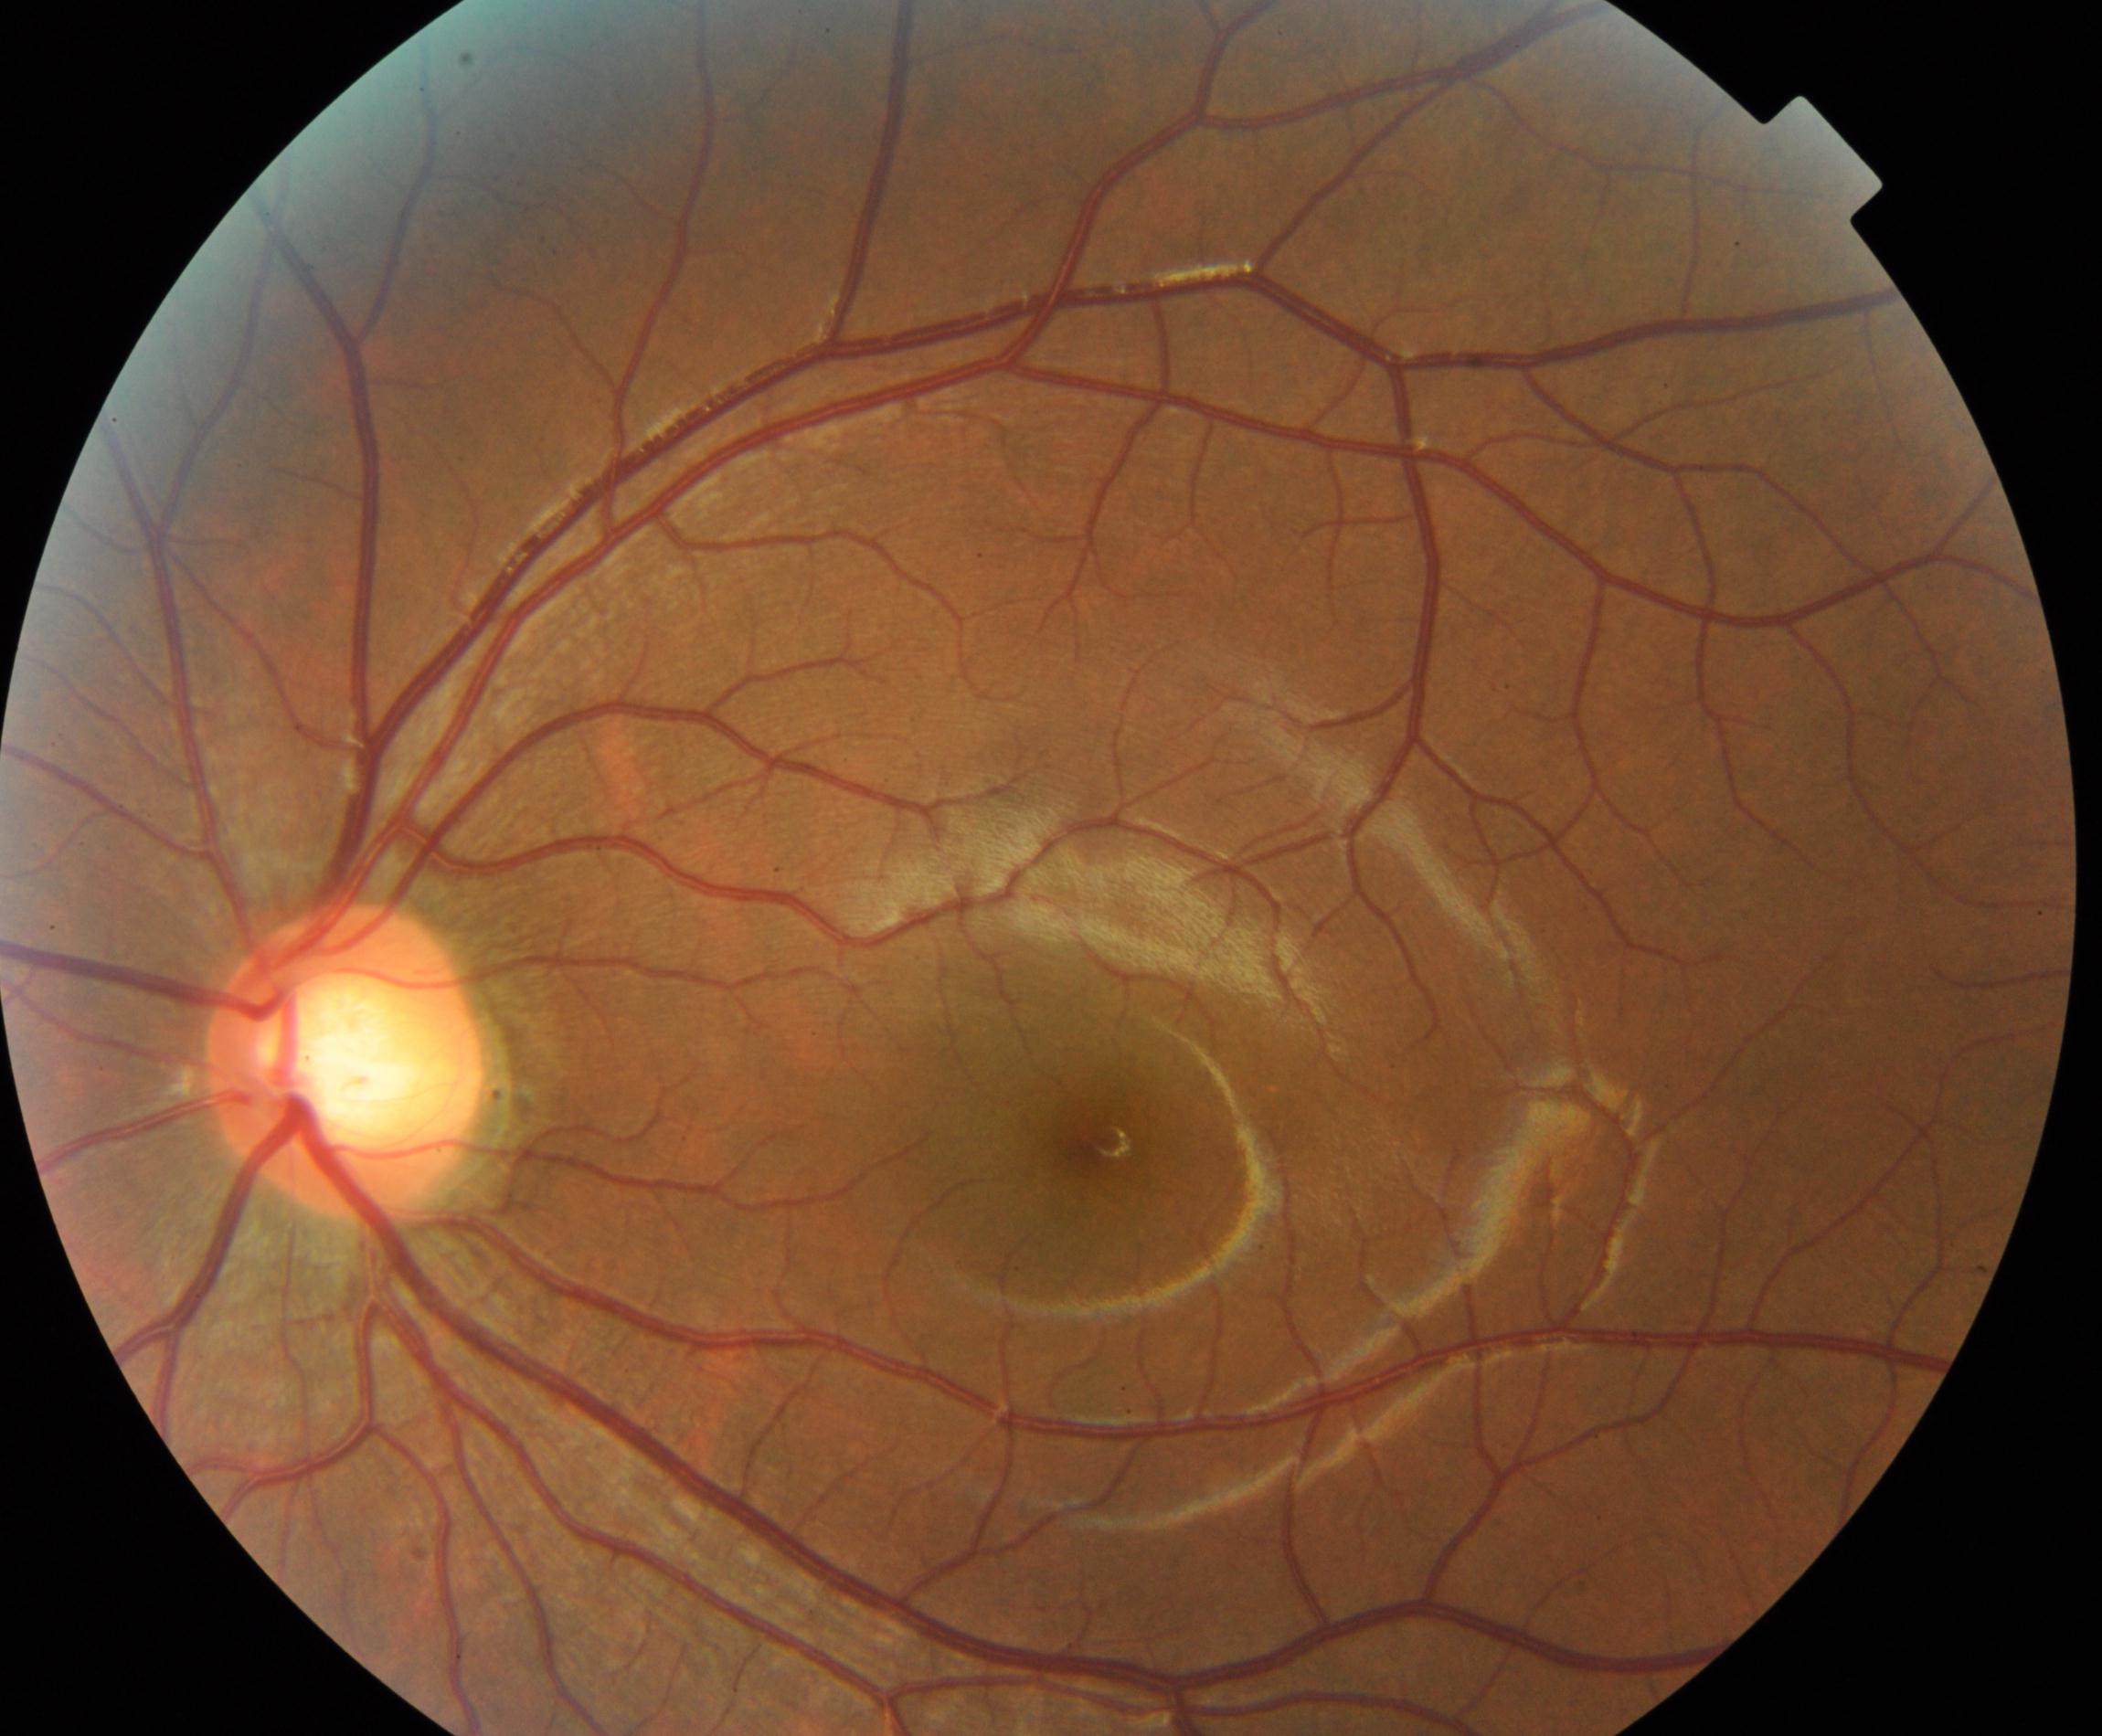
Diagnosis: large optic cup.